50-degree field of view. Fundus photo.
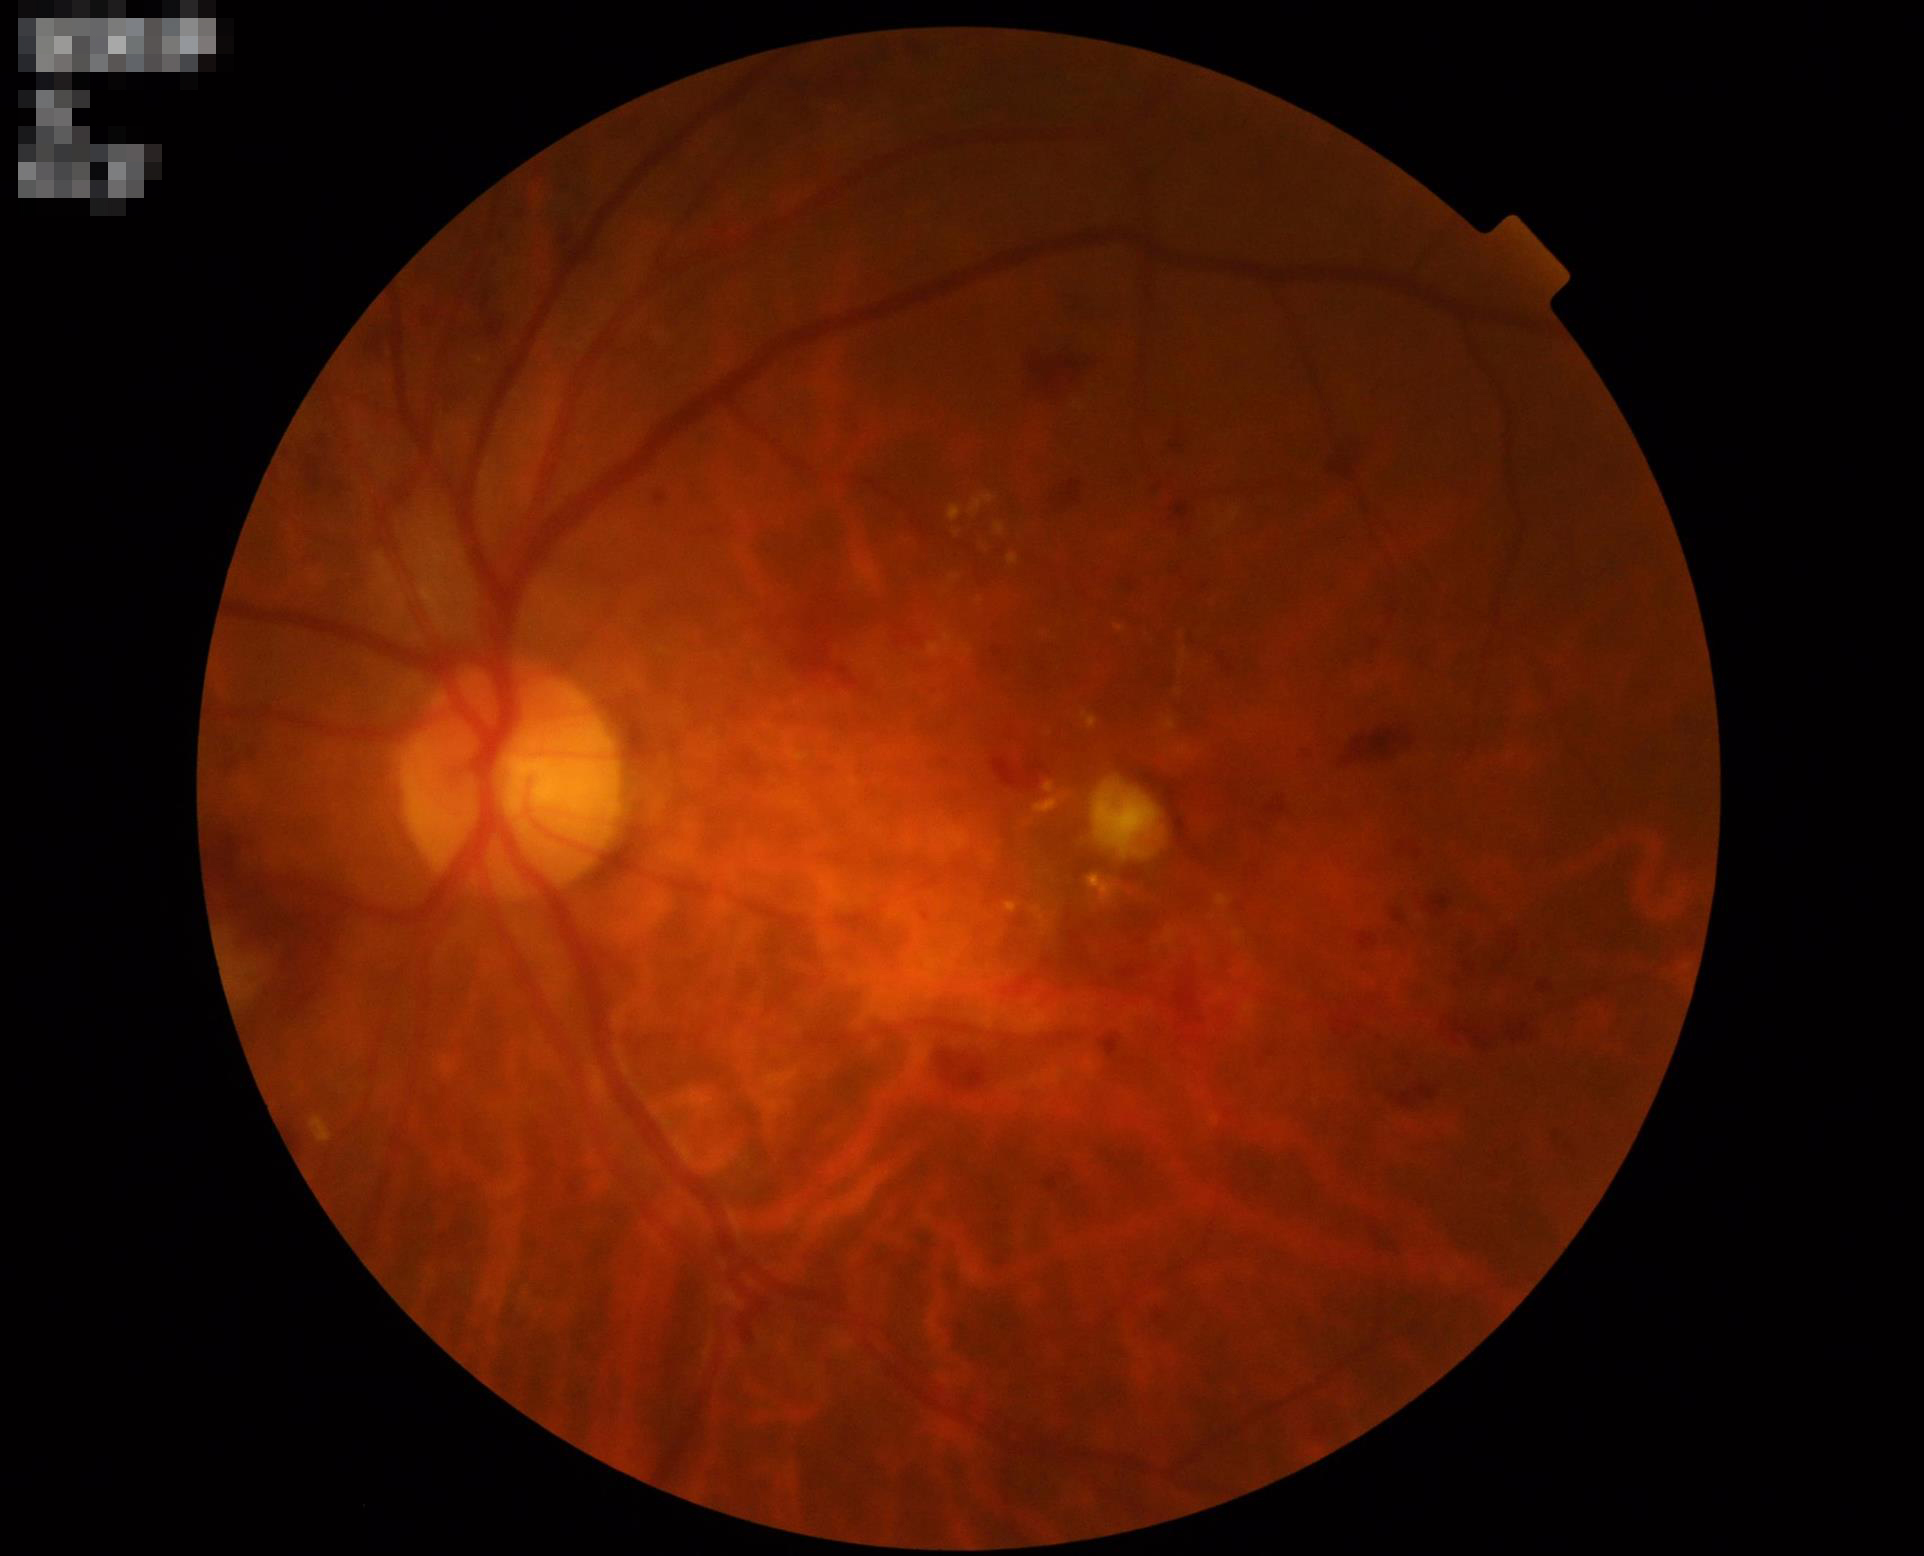 Contrast: good; Overall: adequate; Focus: clear.